Mydriatic acquisition. Optic disc region of a color fundus photo: 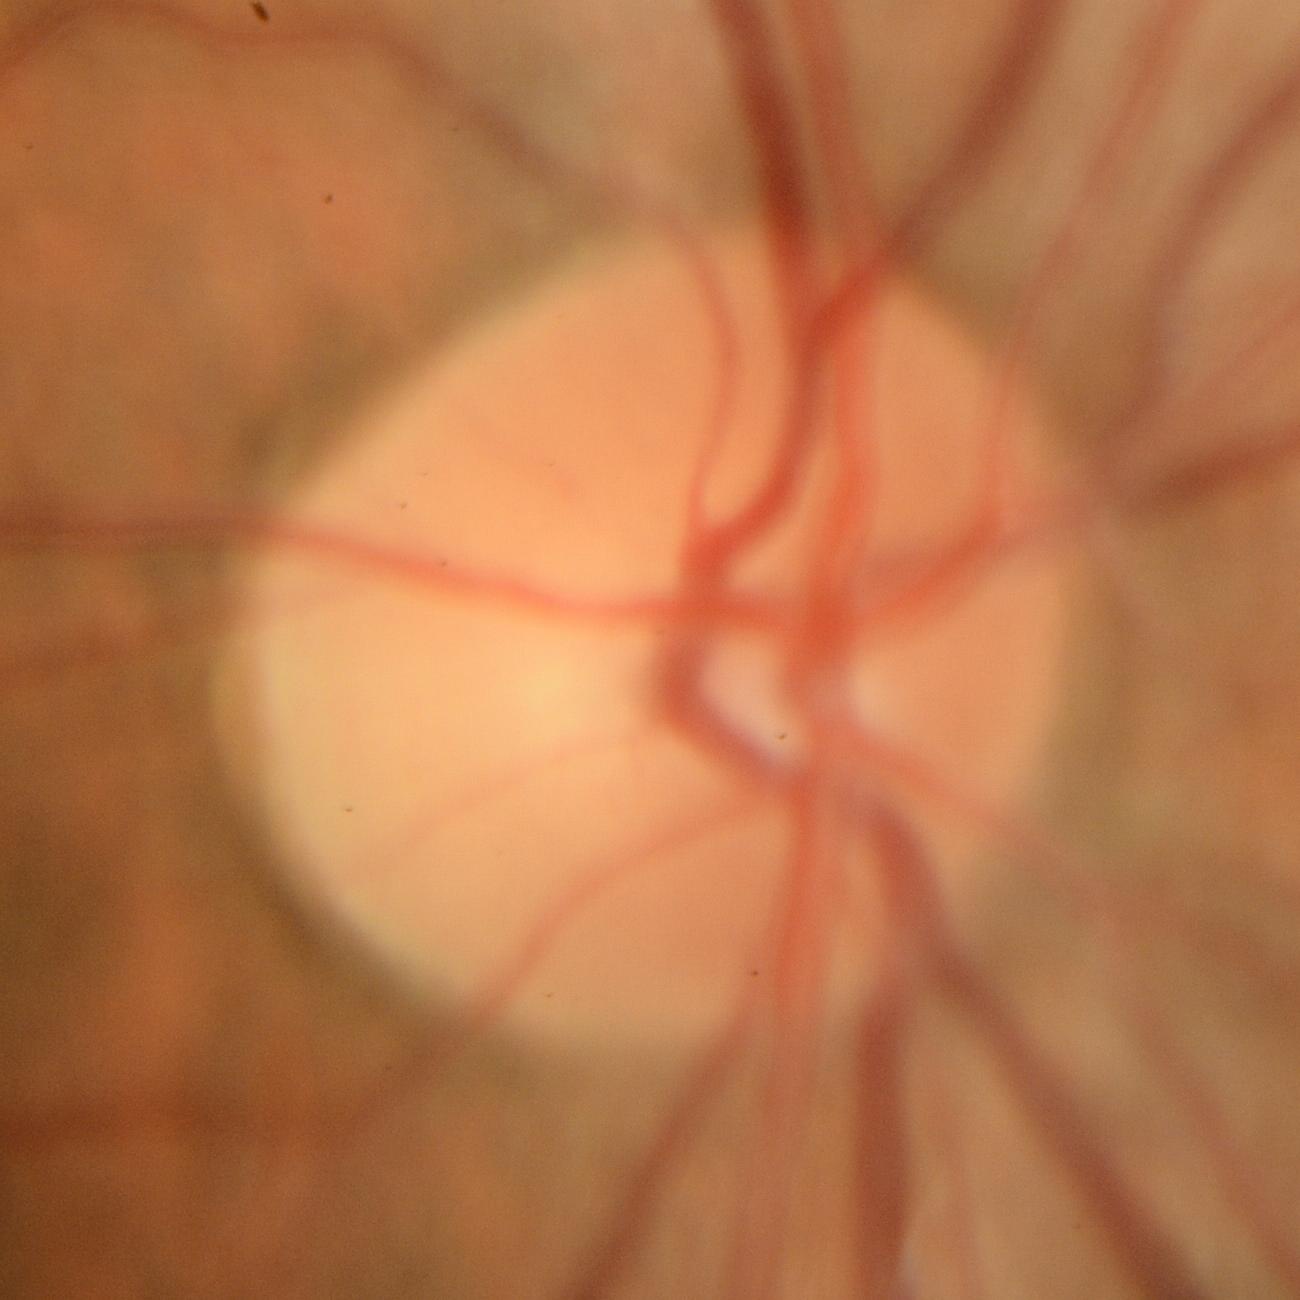
Glaucomatous changes are present. The image shows glaucomatous changes.